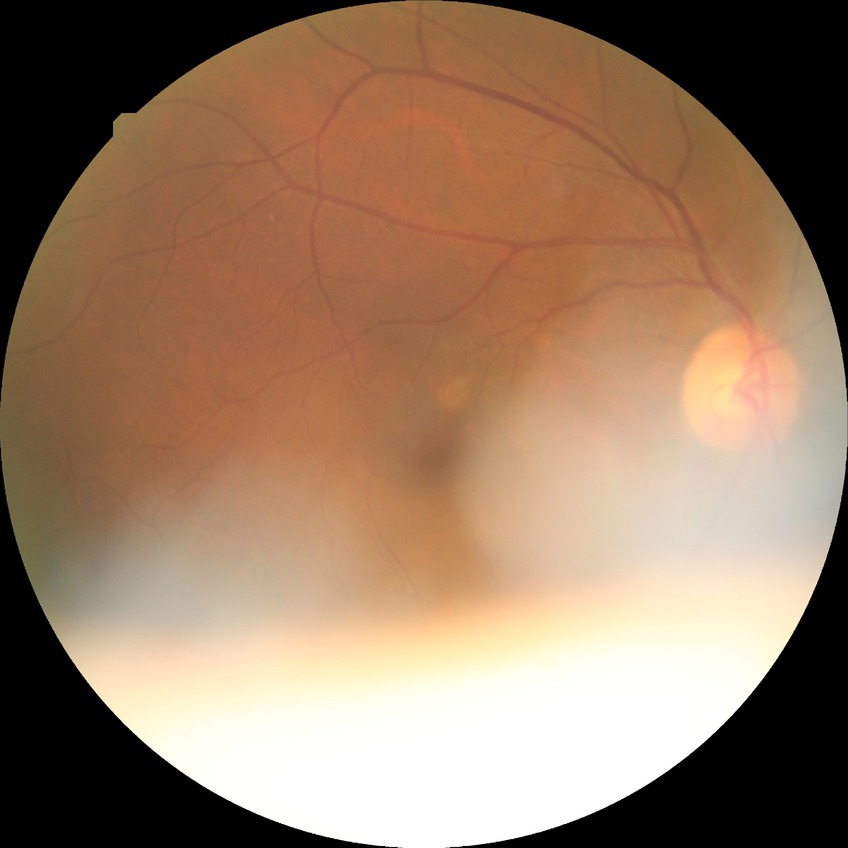
retinopathy stage=no diabetic retinopathy.